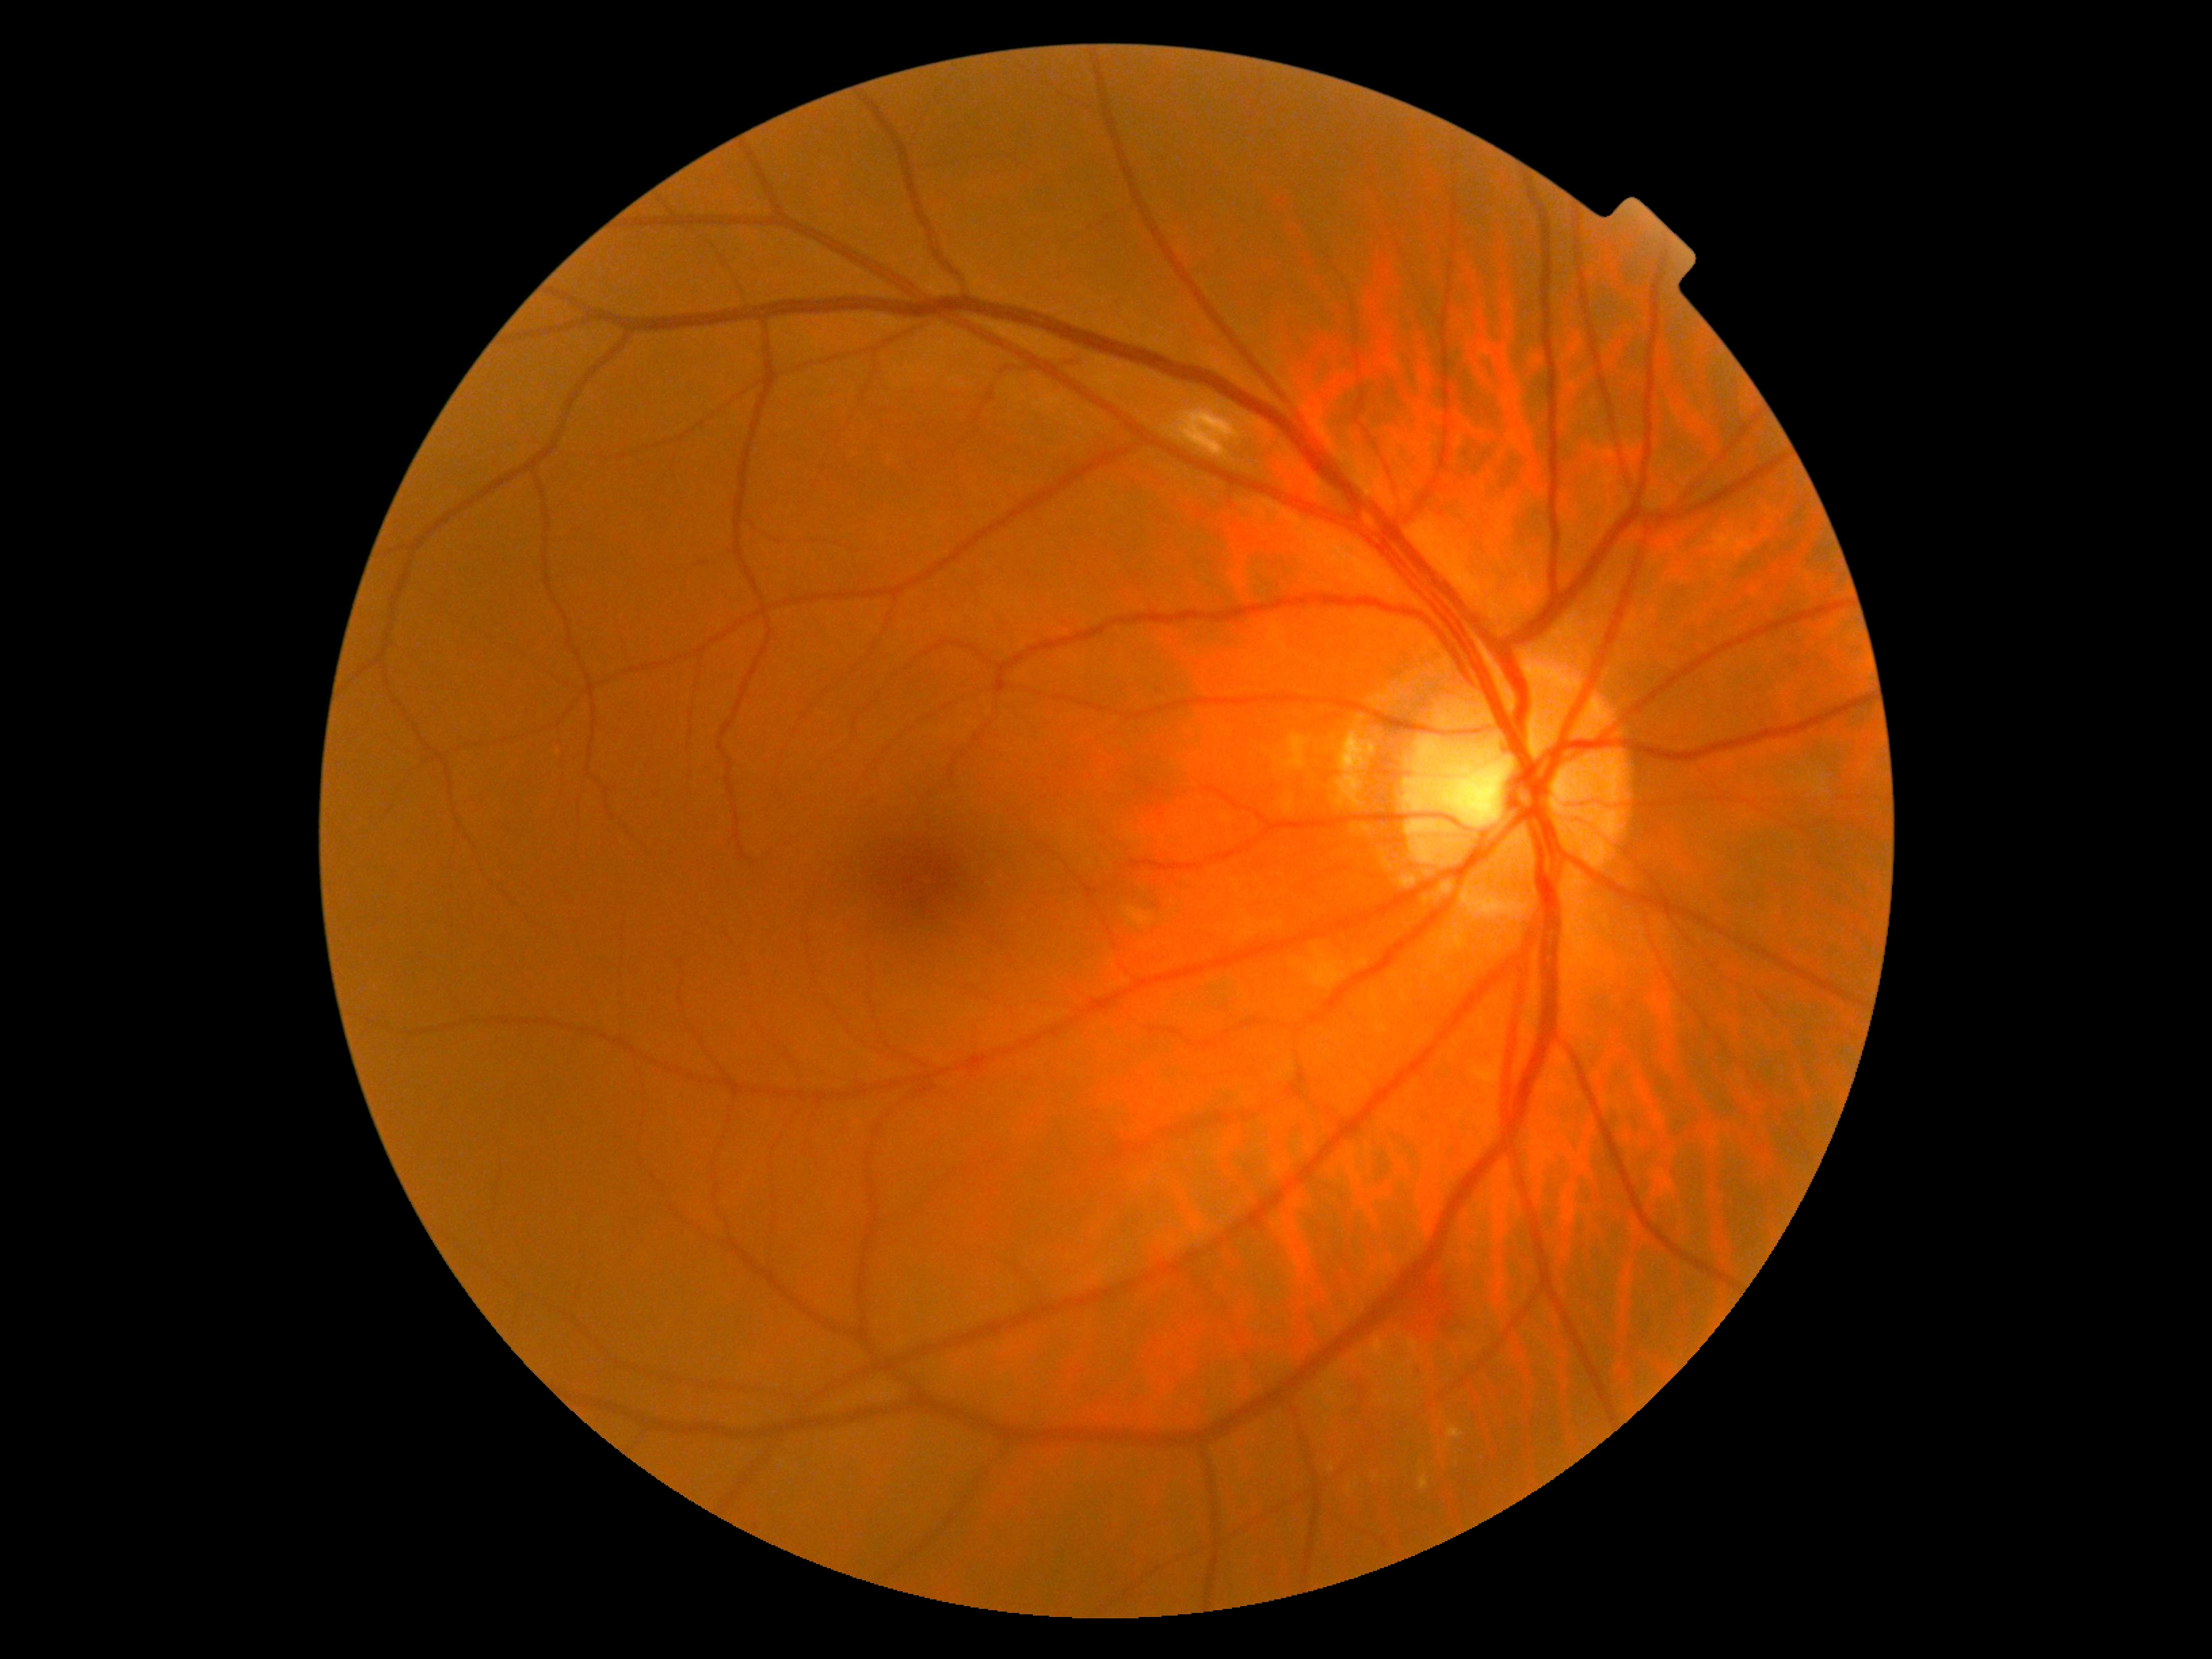

  dr_category: non-proliferative diabetic retinopathy
  dr_grade: 2 (moderate NPDR) — more than just microaneurysms but less than severe NPDR